60° field of view, portable fundus camera image — 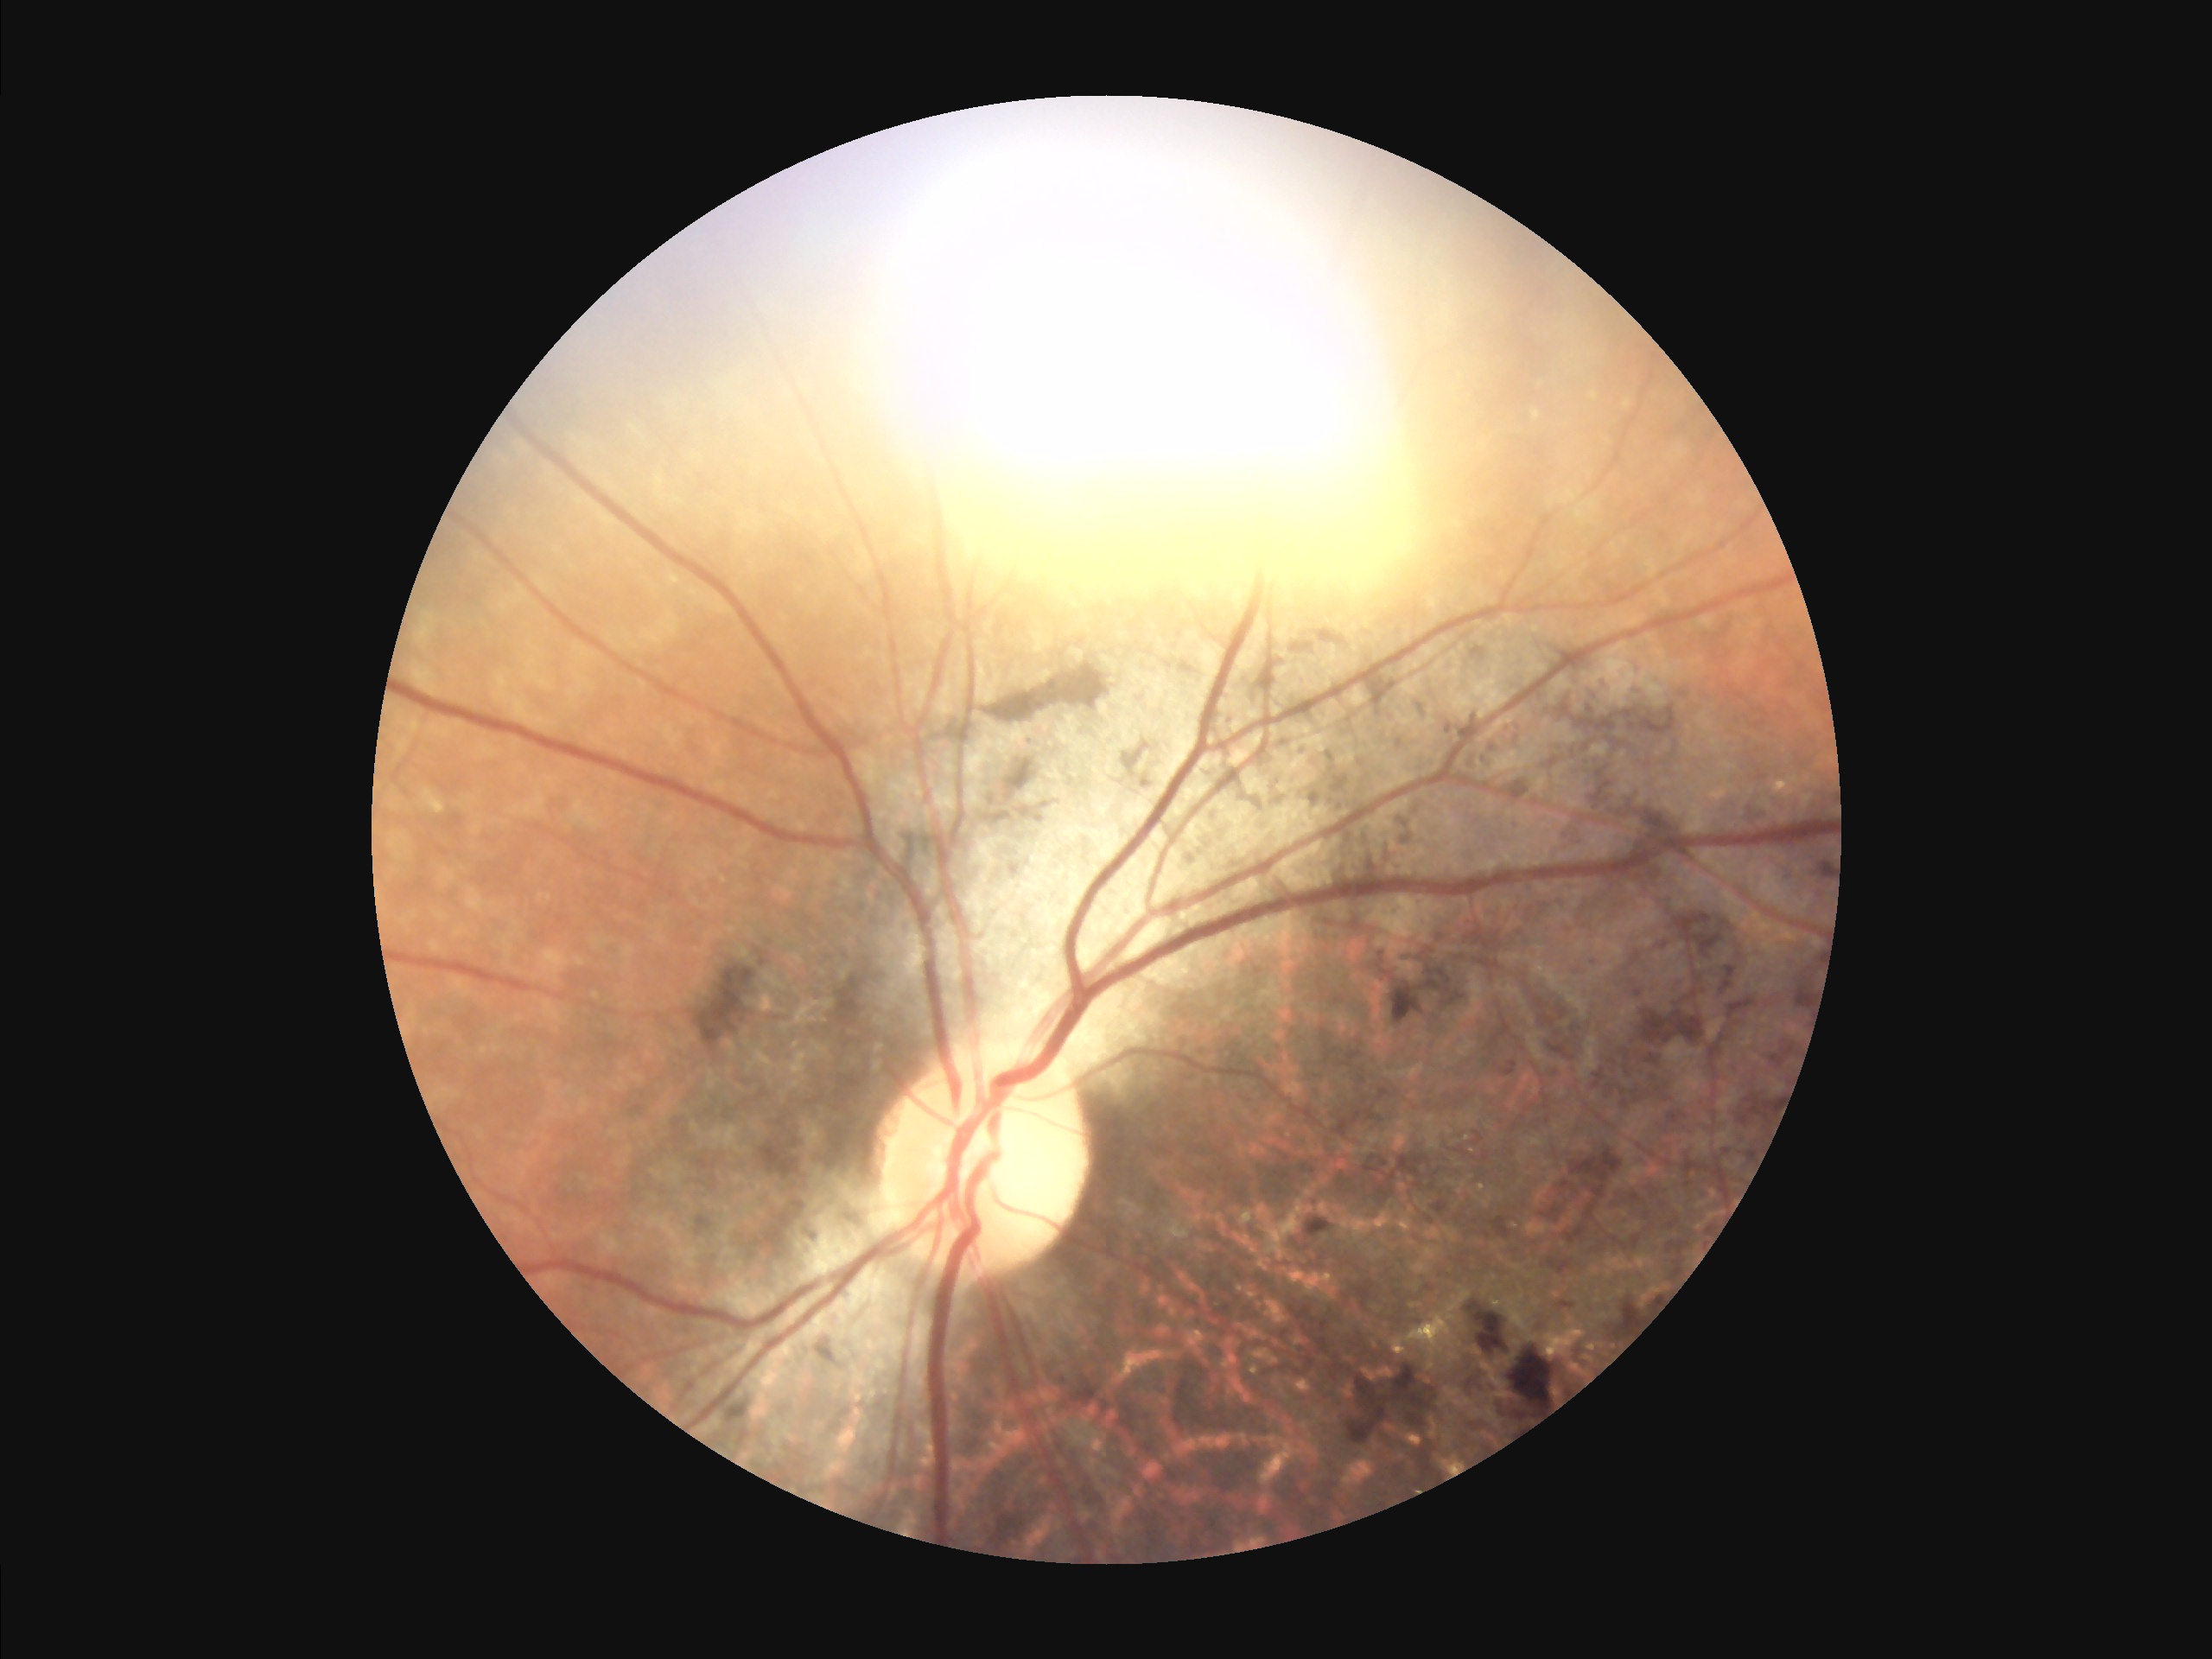
Image quality assessment: focus: optic disc, vessels, and background in focus | overall: poor, ungradable | illumination: uneven illumination or color cast | contrast: vessels and details readily distinguishable.